Modified Davis grading; nonmydriatic; 848 by 848 pixels: 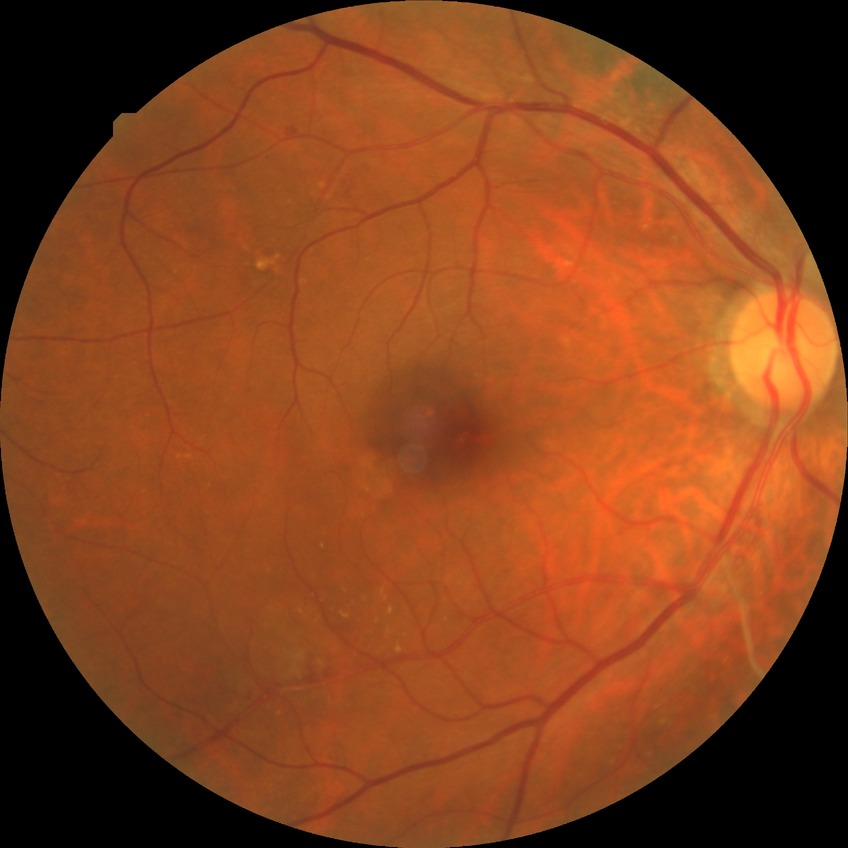

Diabetic retinopathy (DR) is SDR (simple diabetic retinopathy).